Clarity RetCam 3, 130° FOV · wide-field fundus image from infant ROP screening:
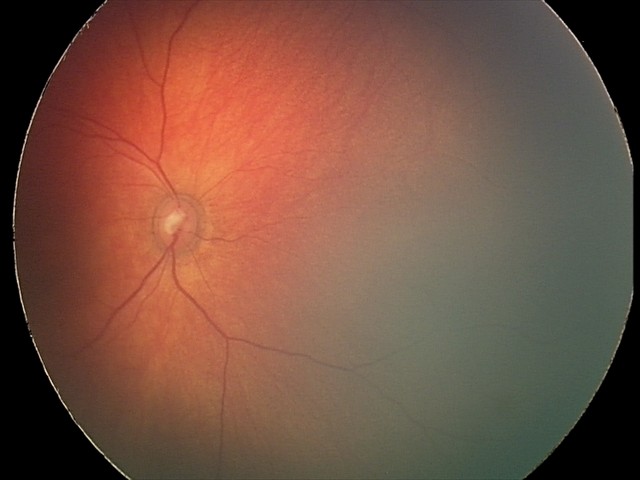 Screening examination consistent with retinal hemorrhages.